2212x1659 · color fundus image: 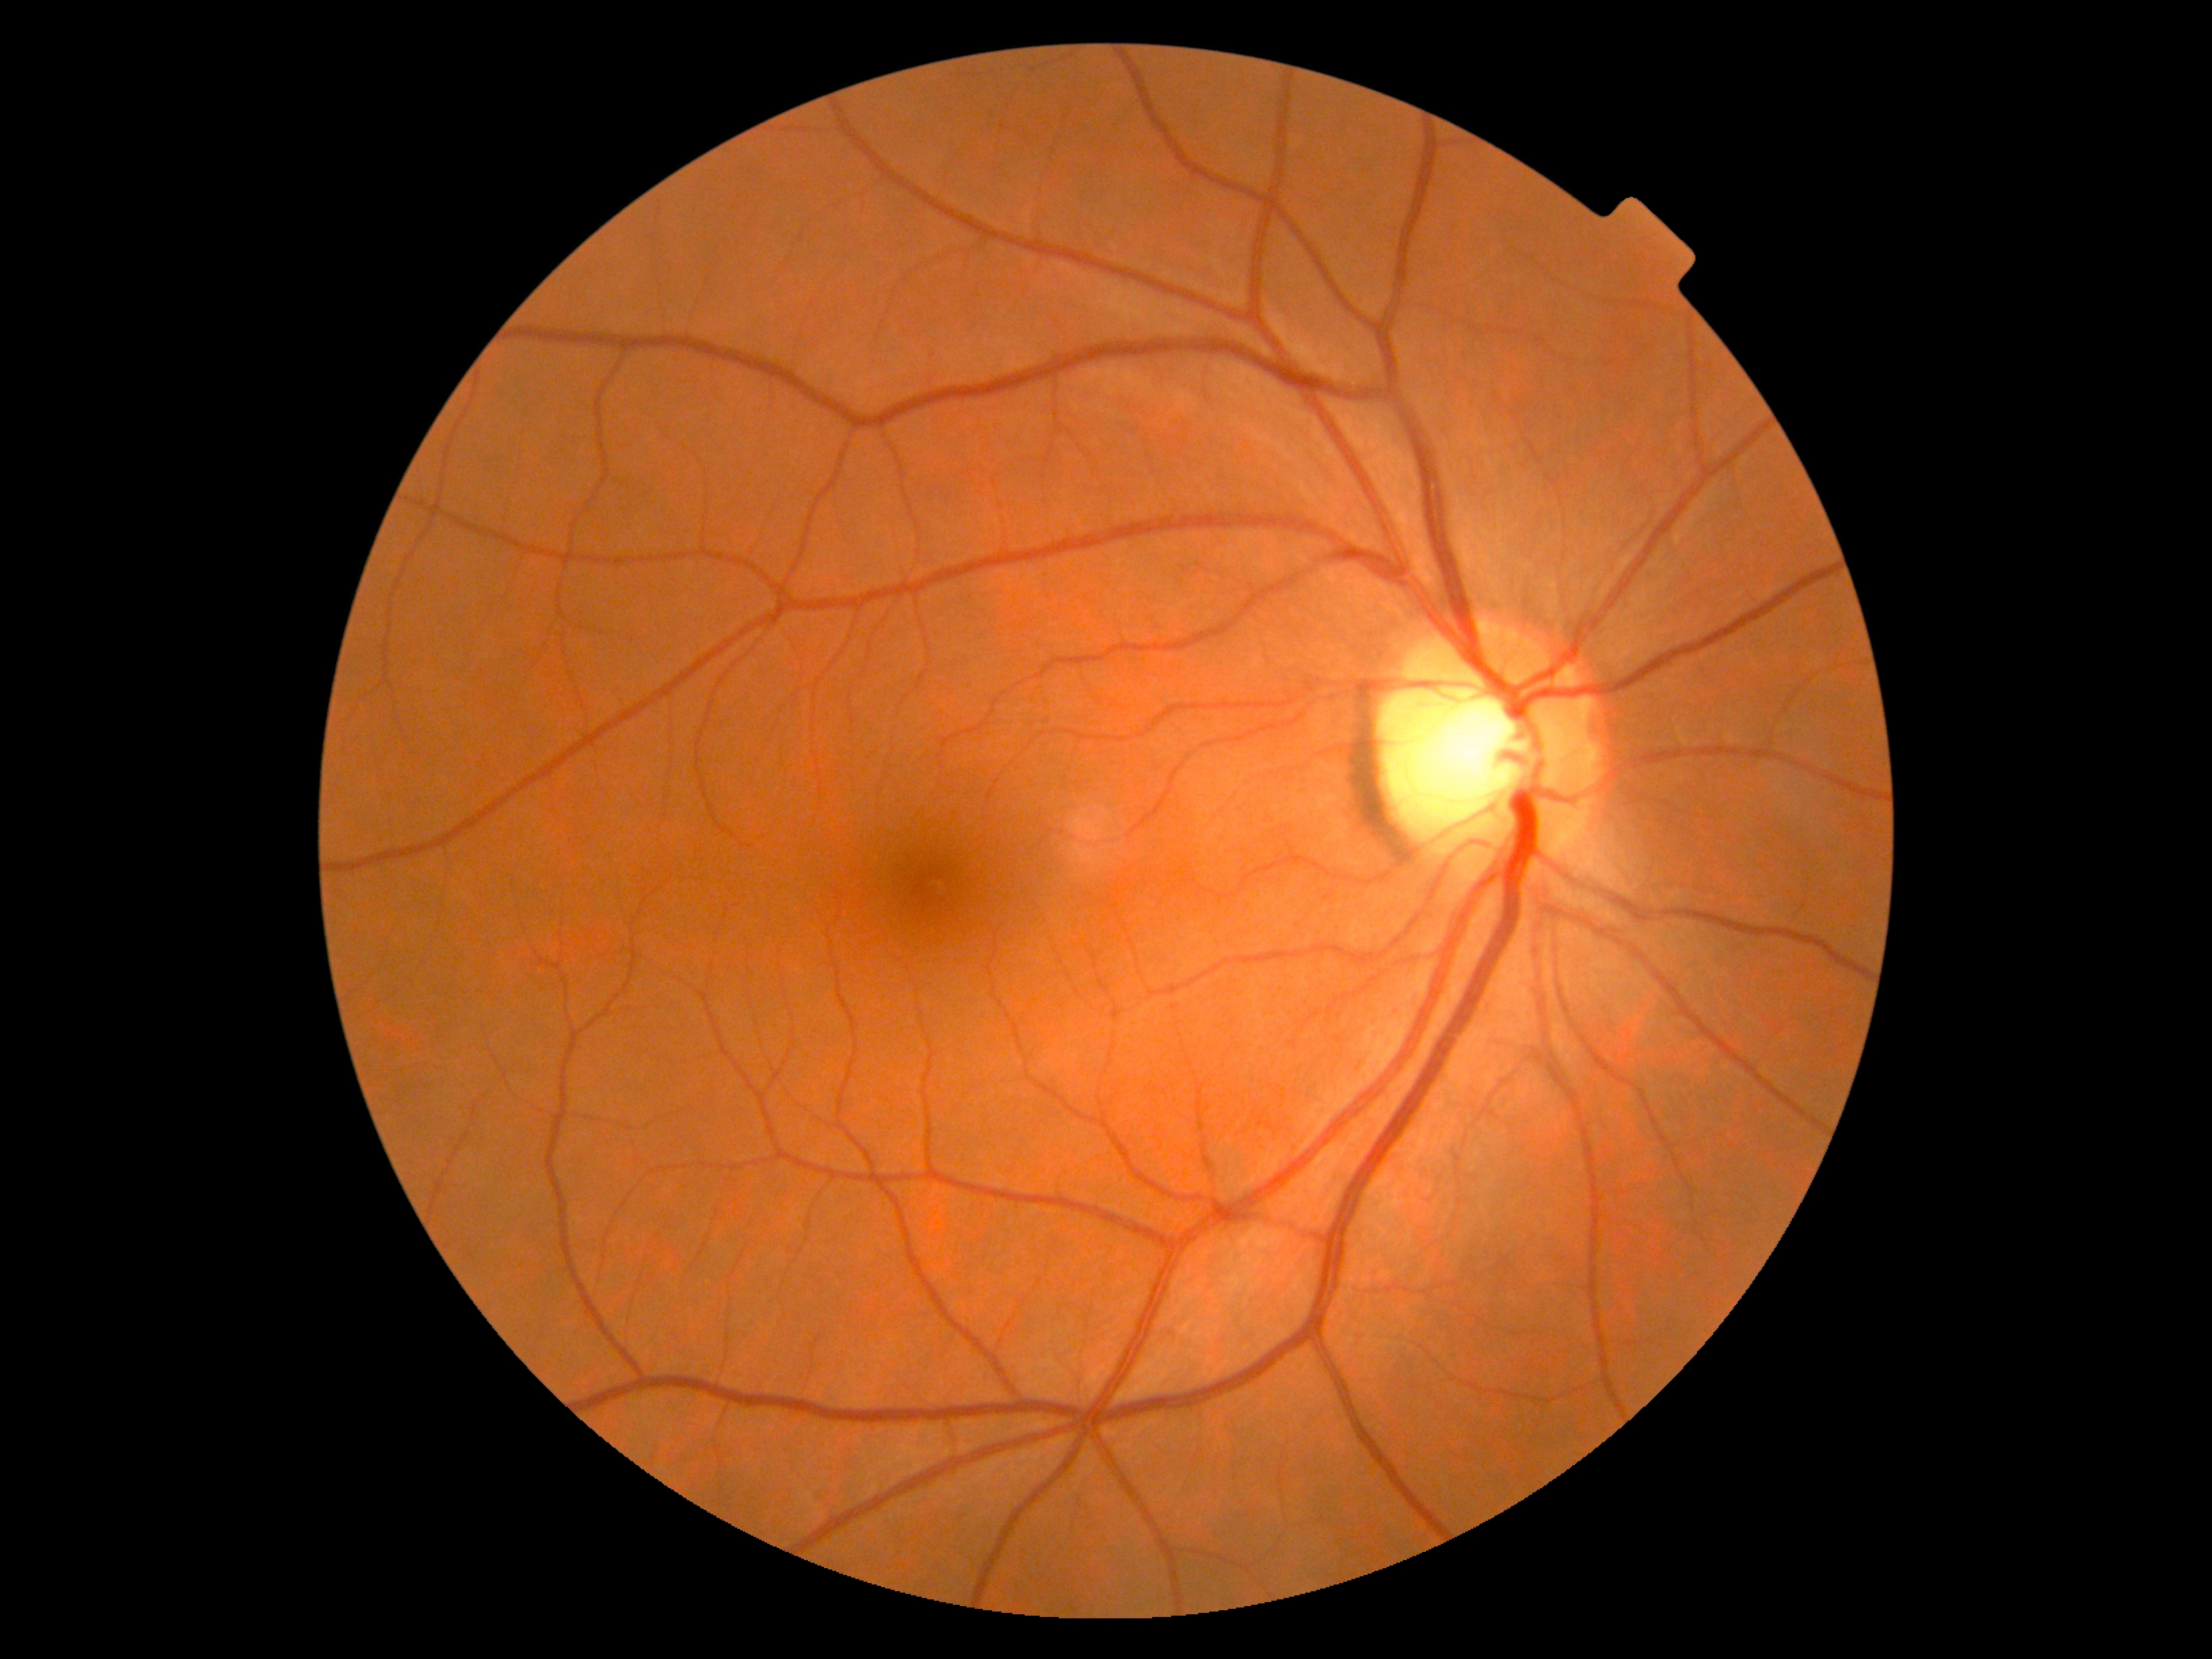

diabetic retinopathy = 0
DR impression = no apparent DR